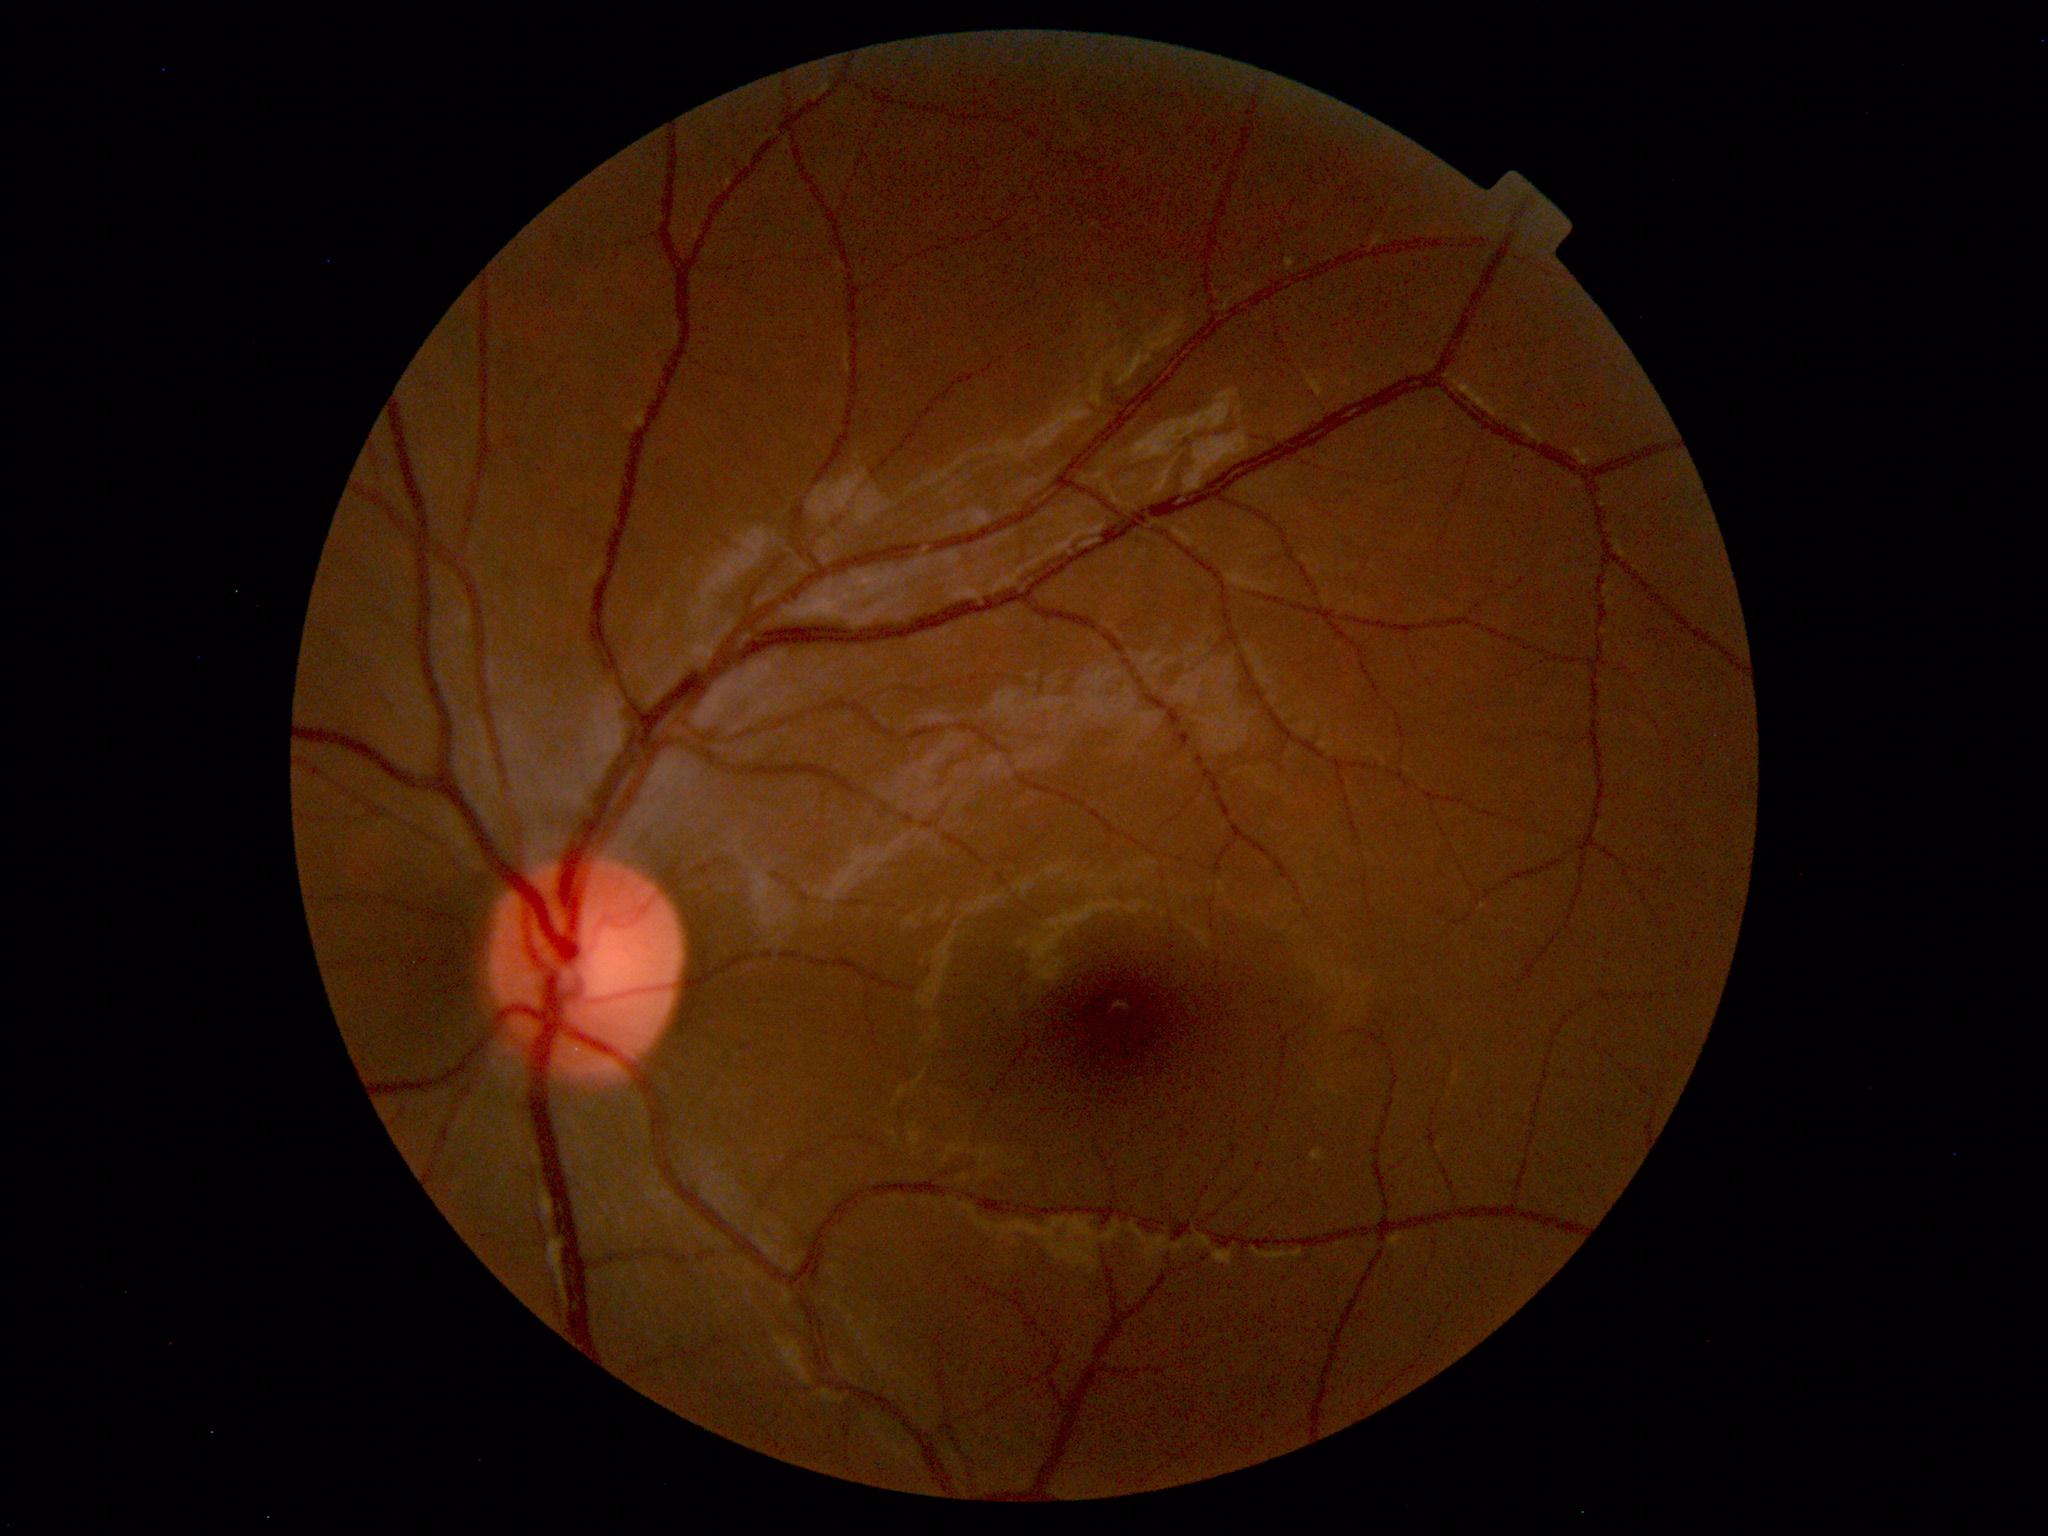

Findings: no abnormalities.